Undilated pupil.
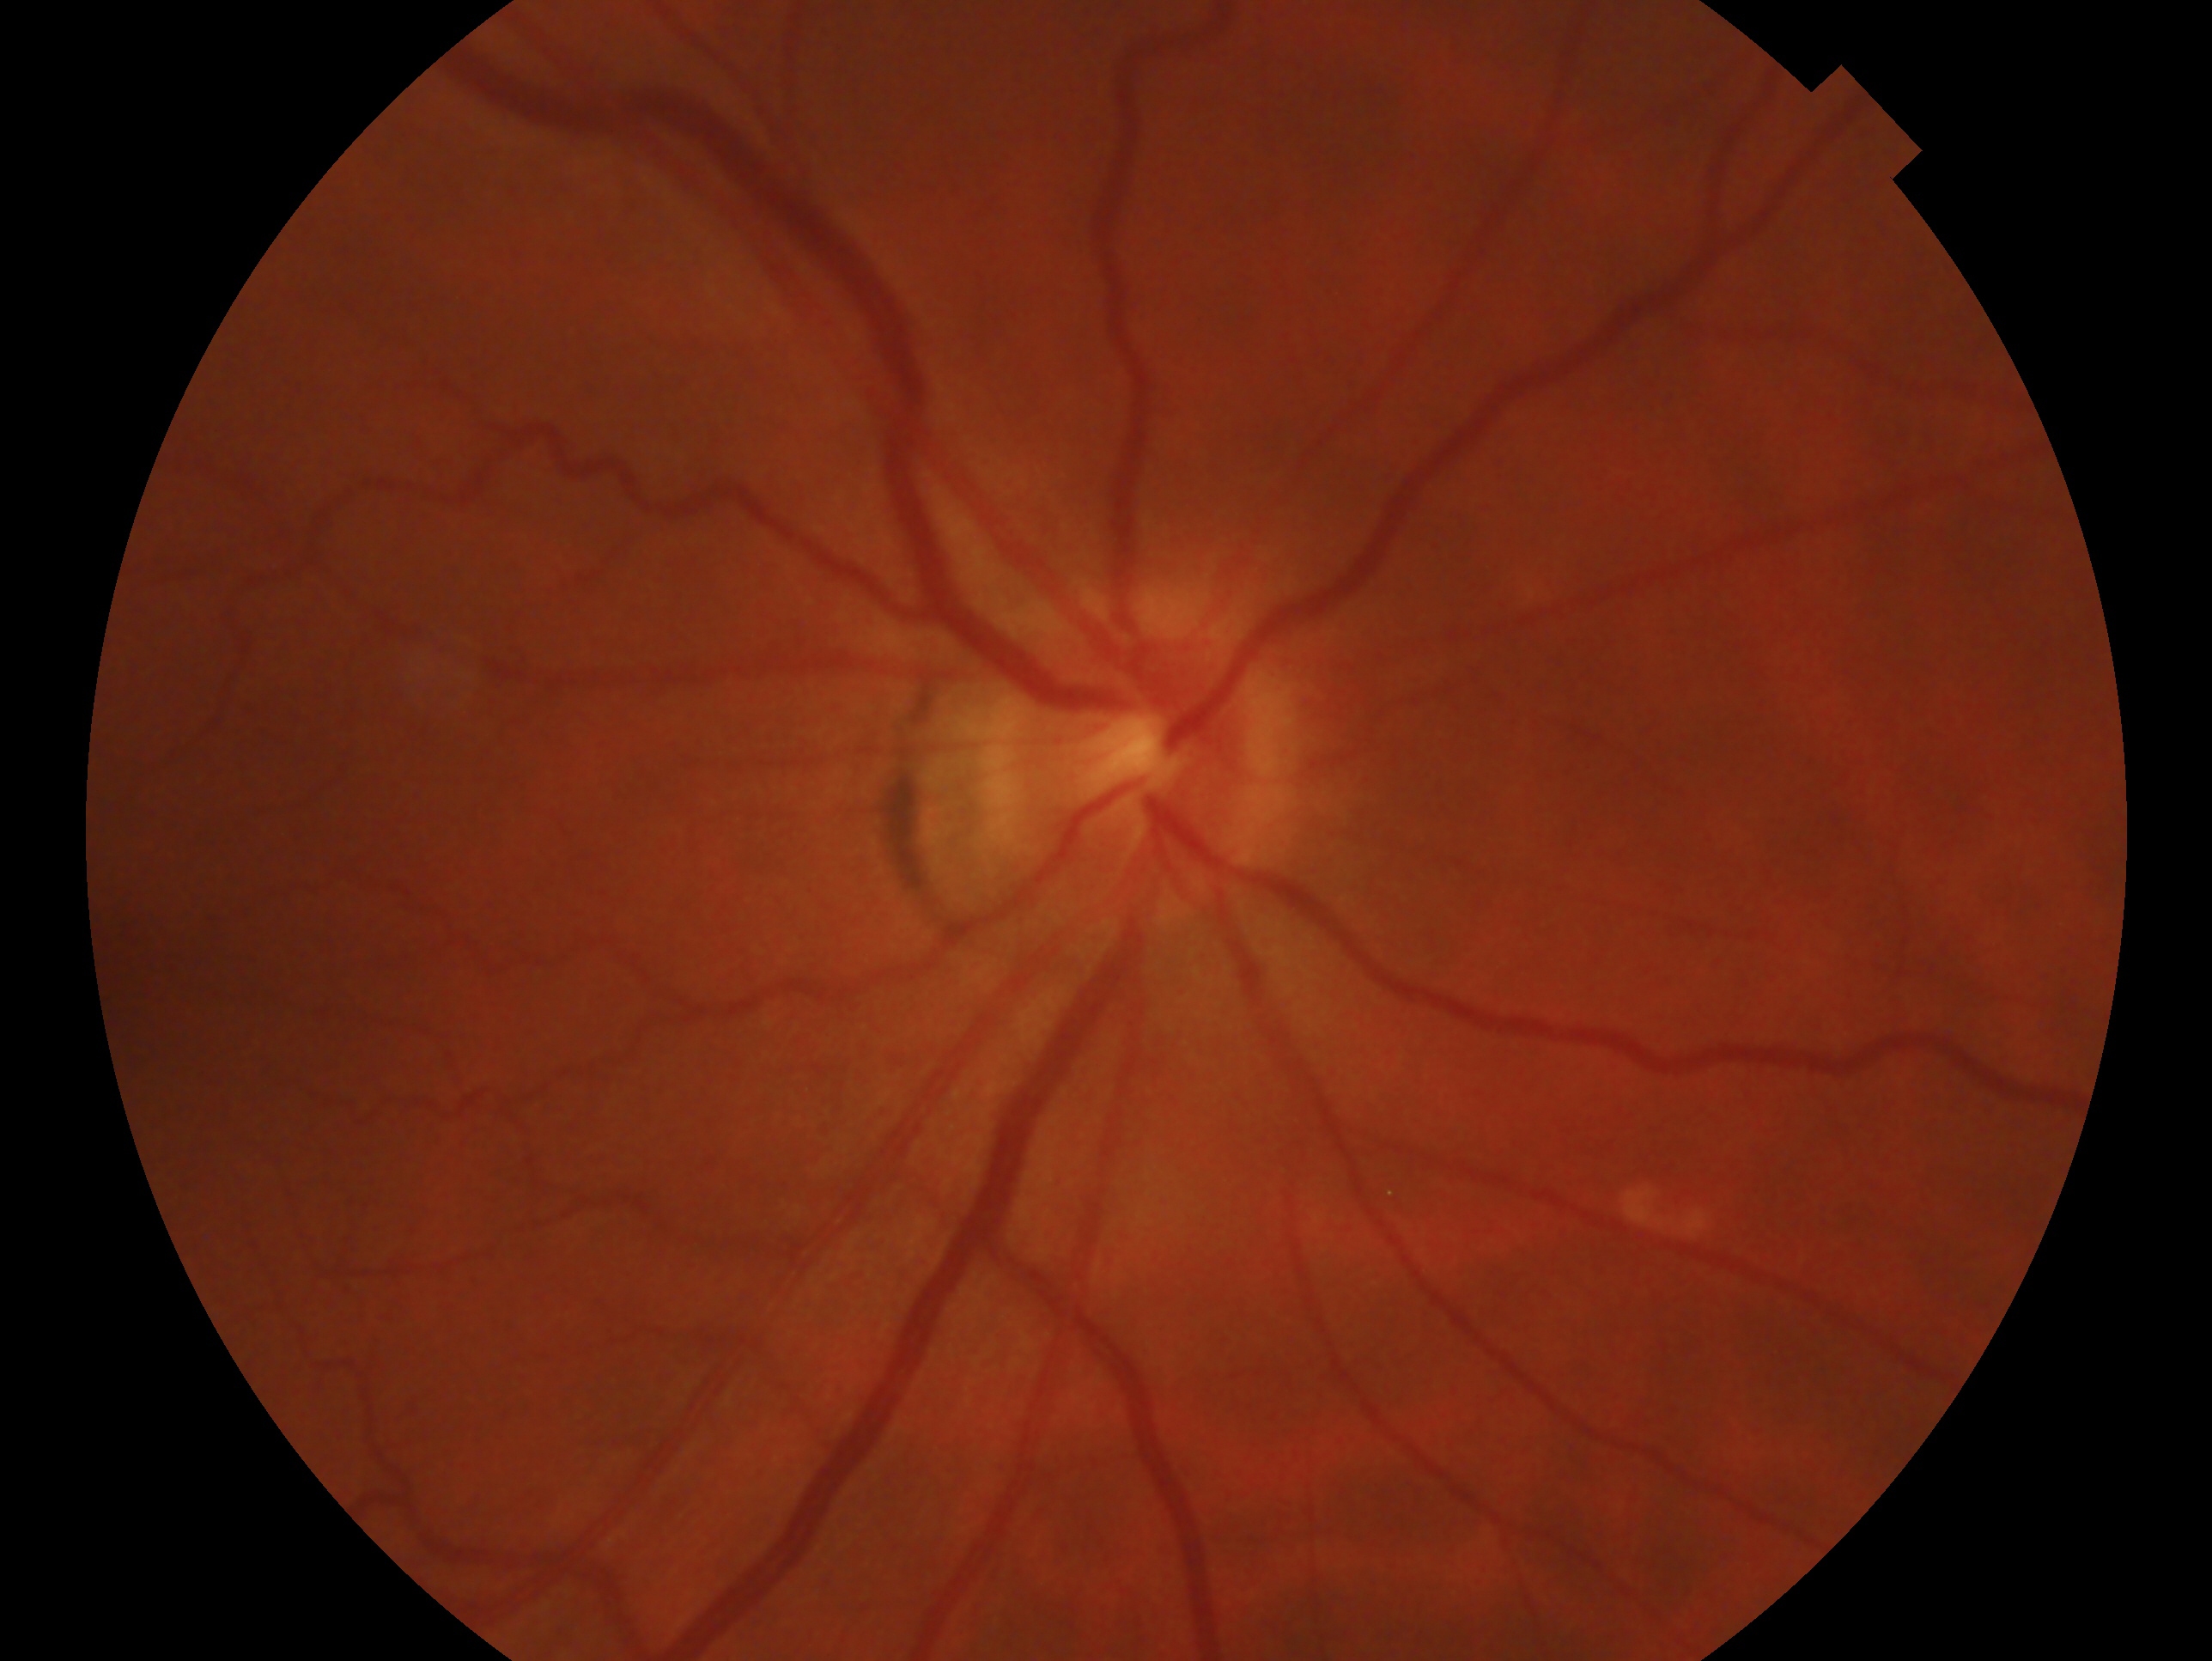
assessment=no evidence of glaucoma; laterality=oculus dexter.